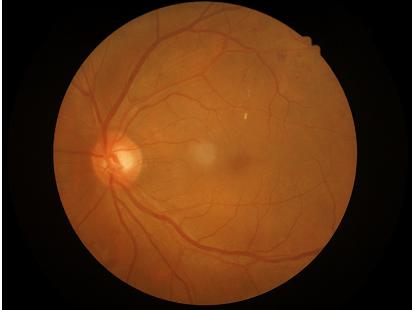 Even illumination with no color cast.